Wide-field fundus image from infant ROP screening.
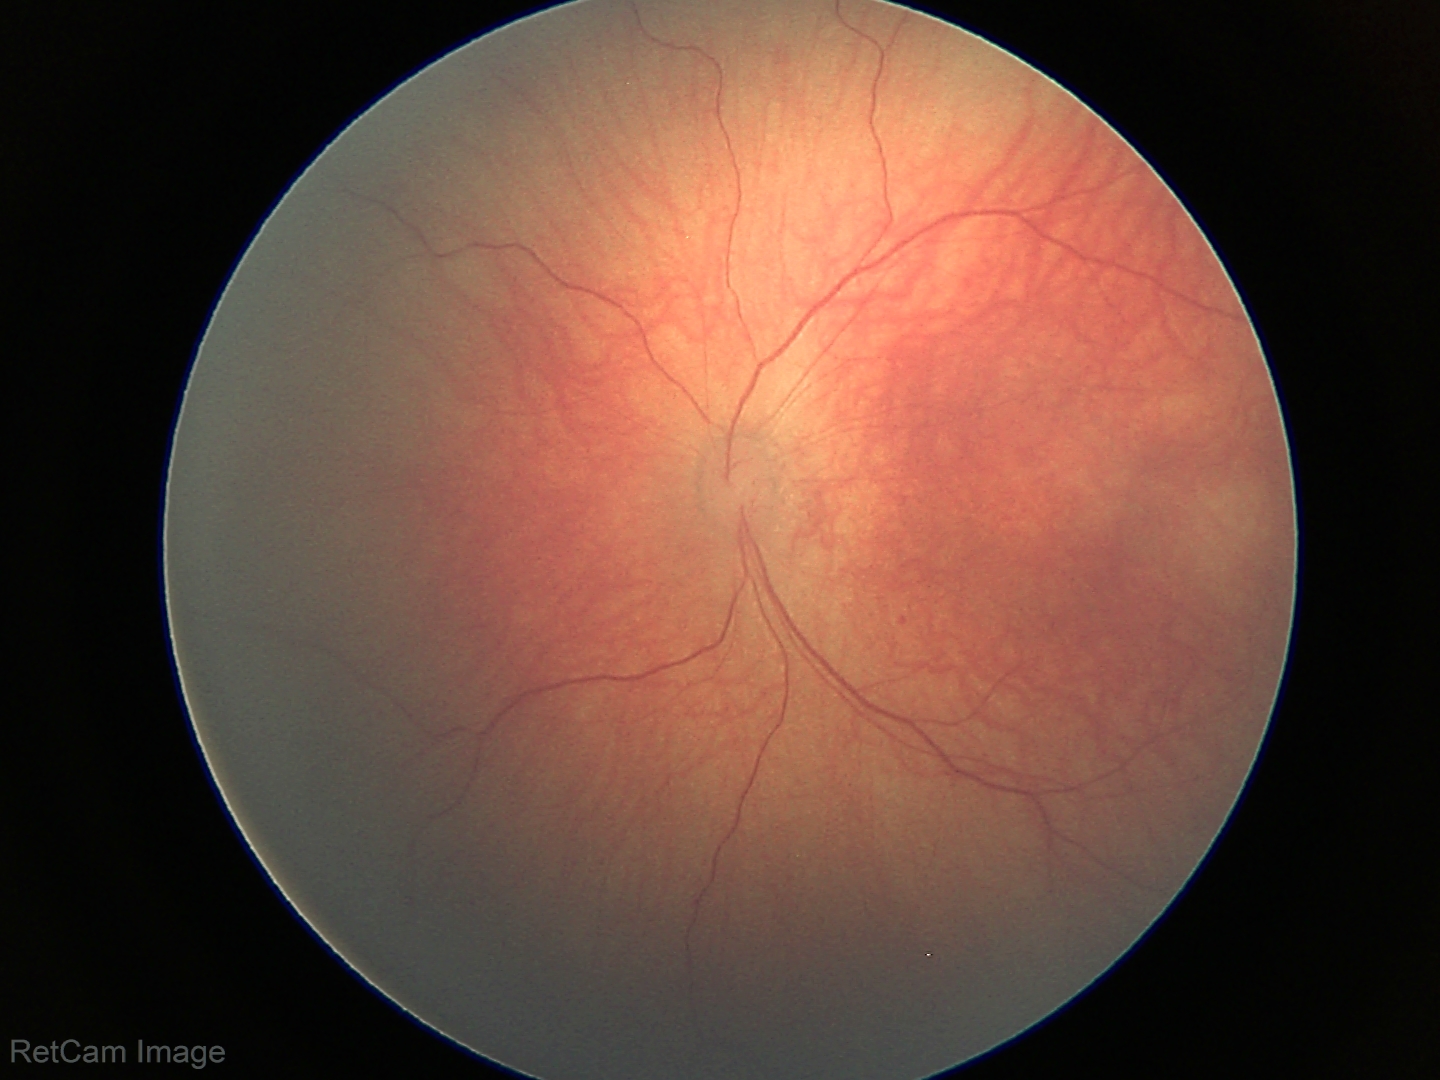

Q: What is the diagnosis from this examination?
A: physiological retinal finding